Pediatric retinal photograph (wide-field) — 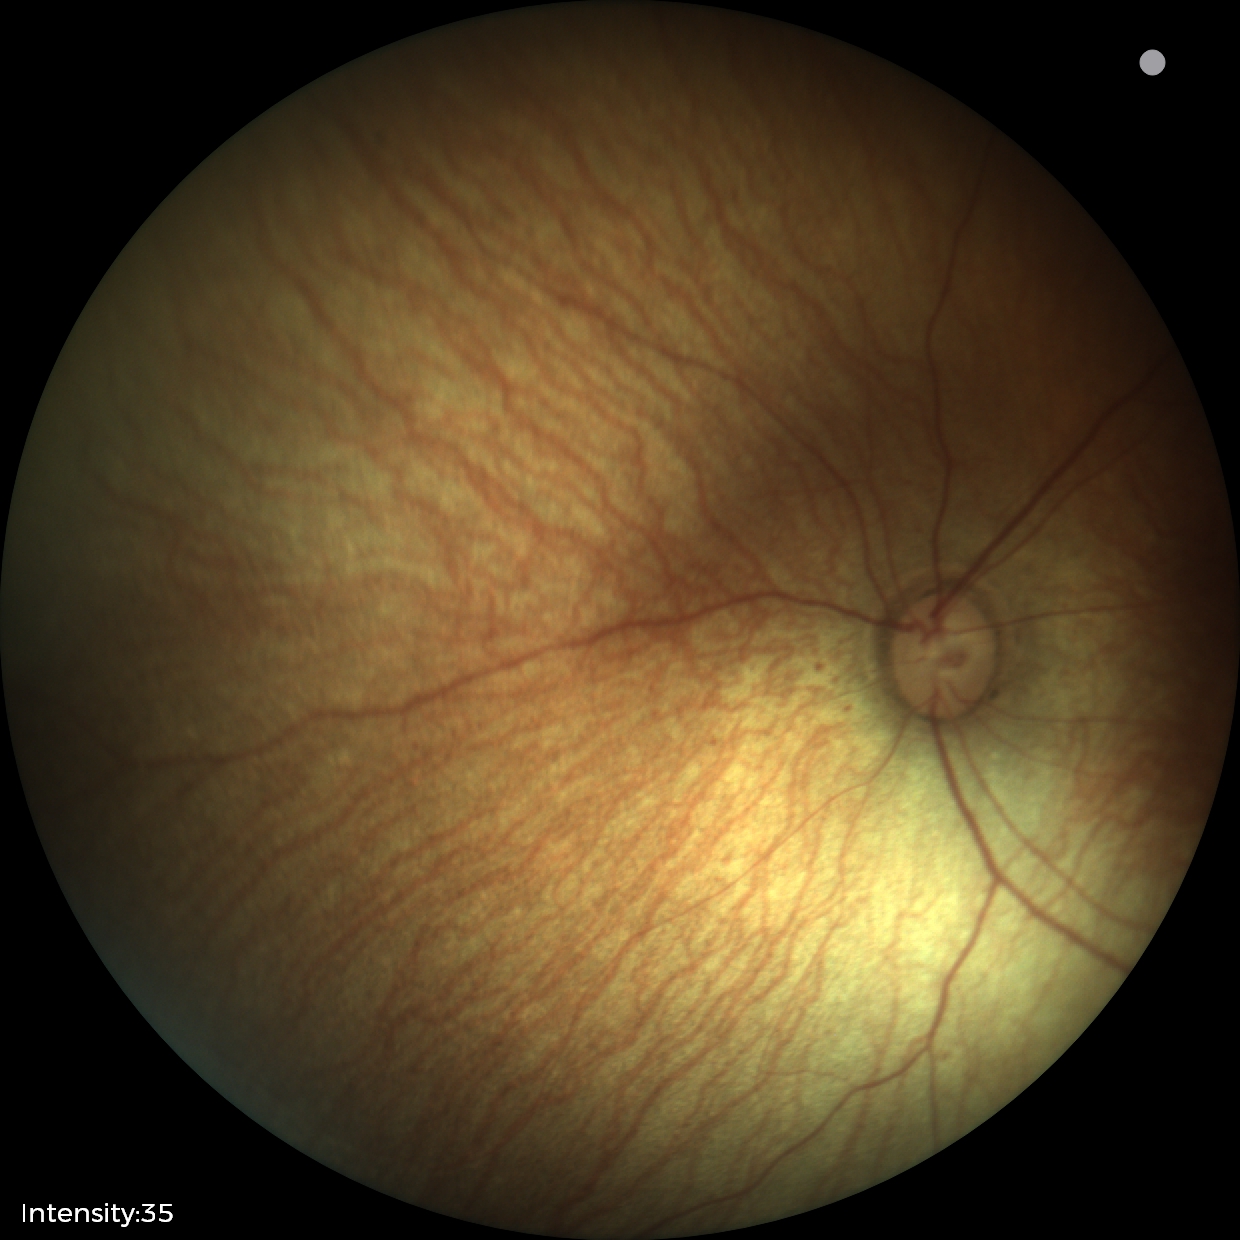 Impression: physiological finding.